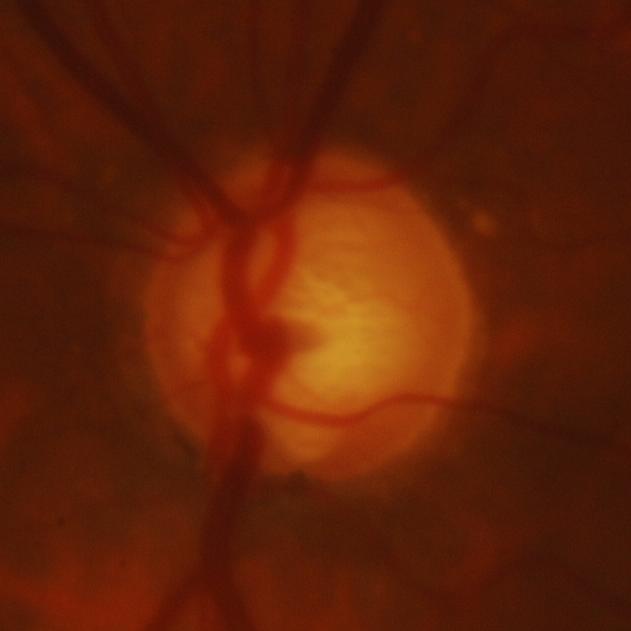

Assessment = glaucomatous changes.